Color fundus image, 2352x1568px, FOV: 45 degrees.
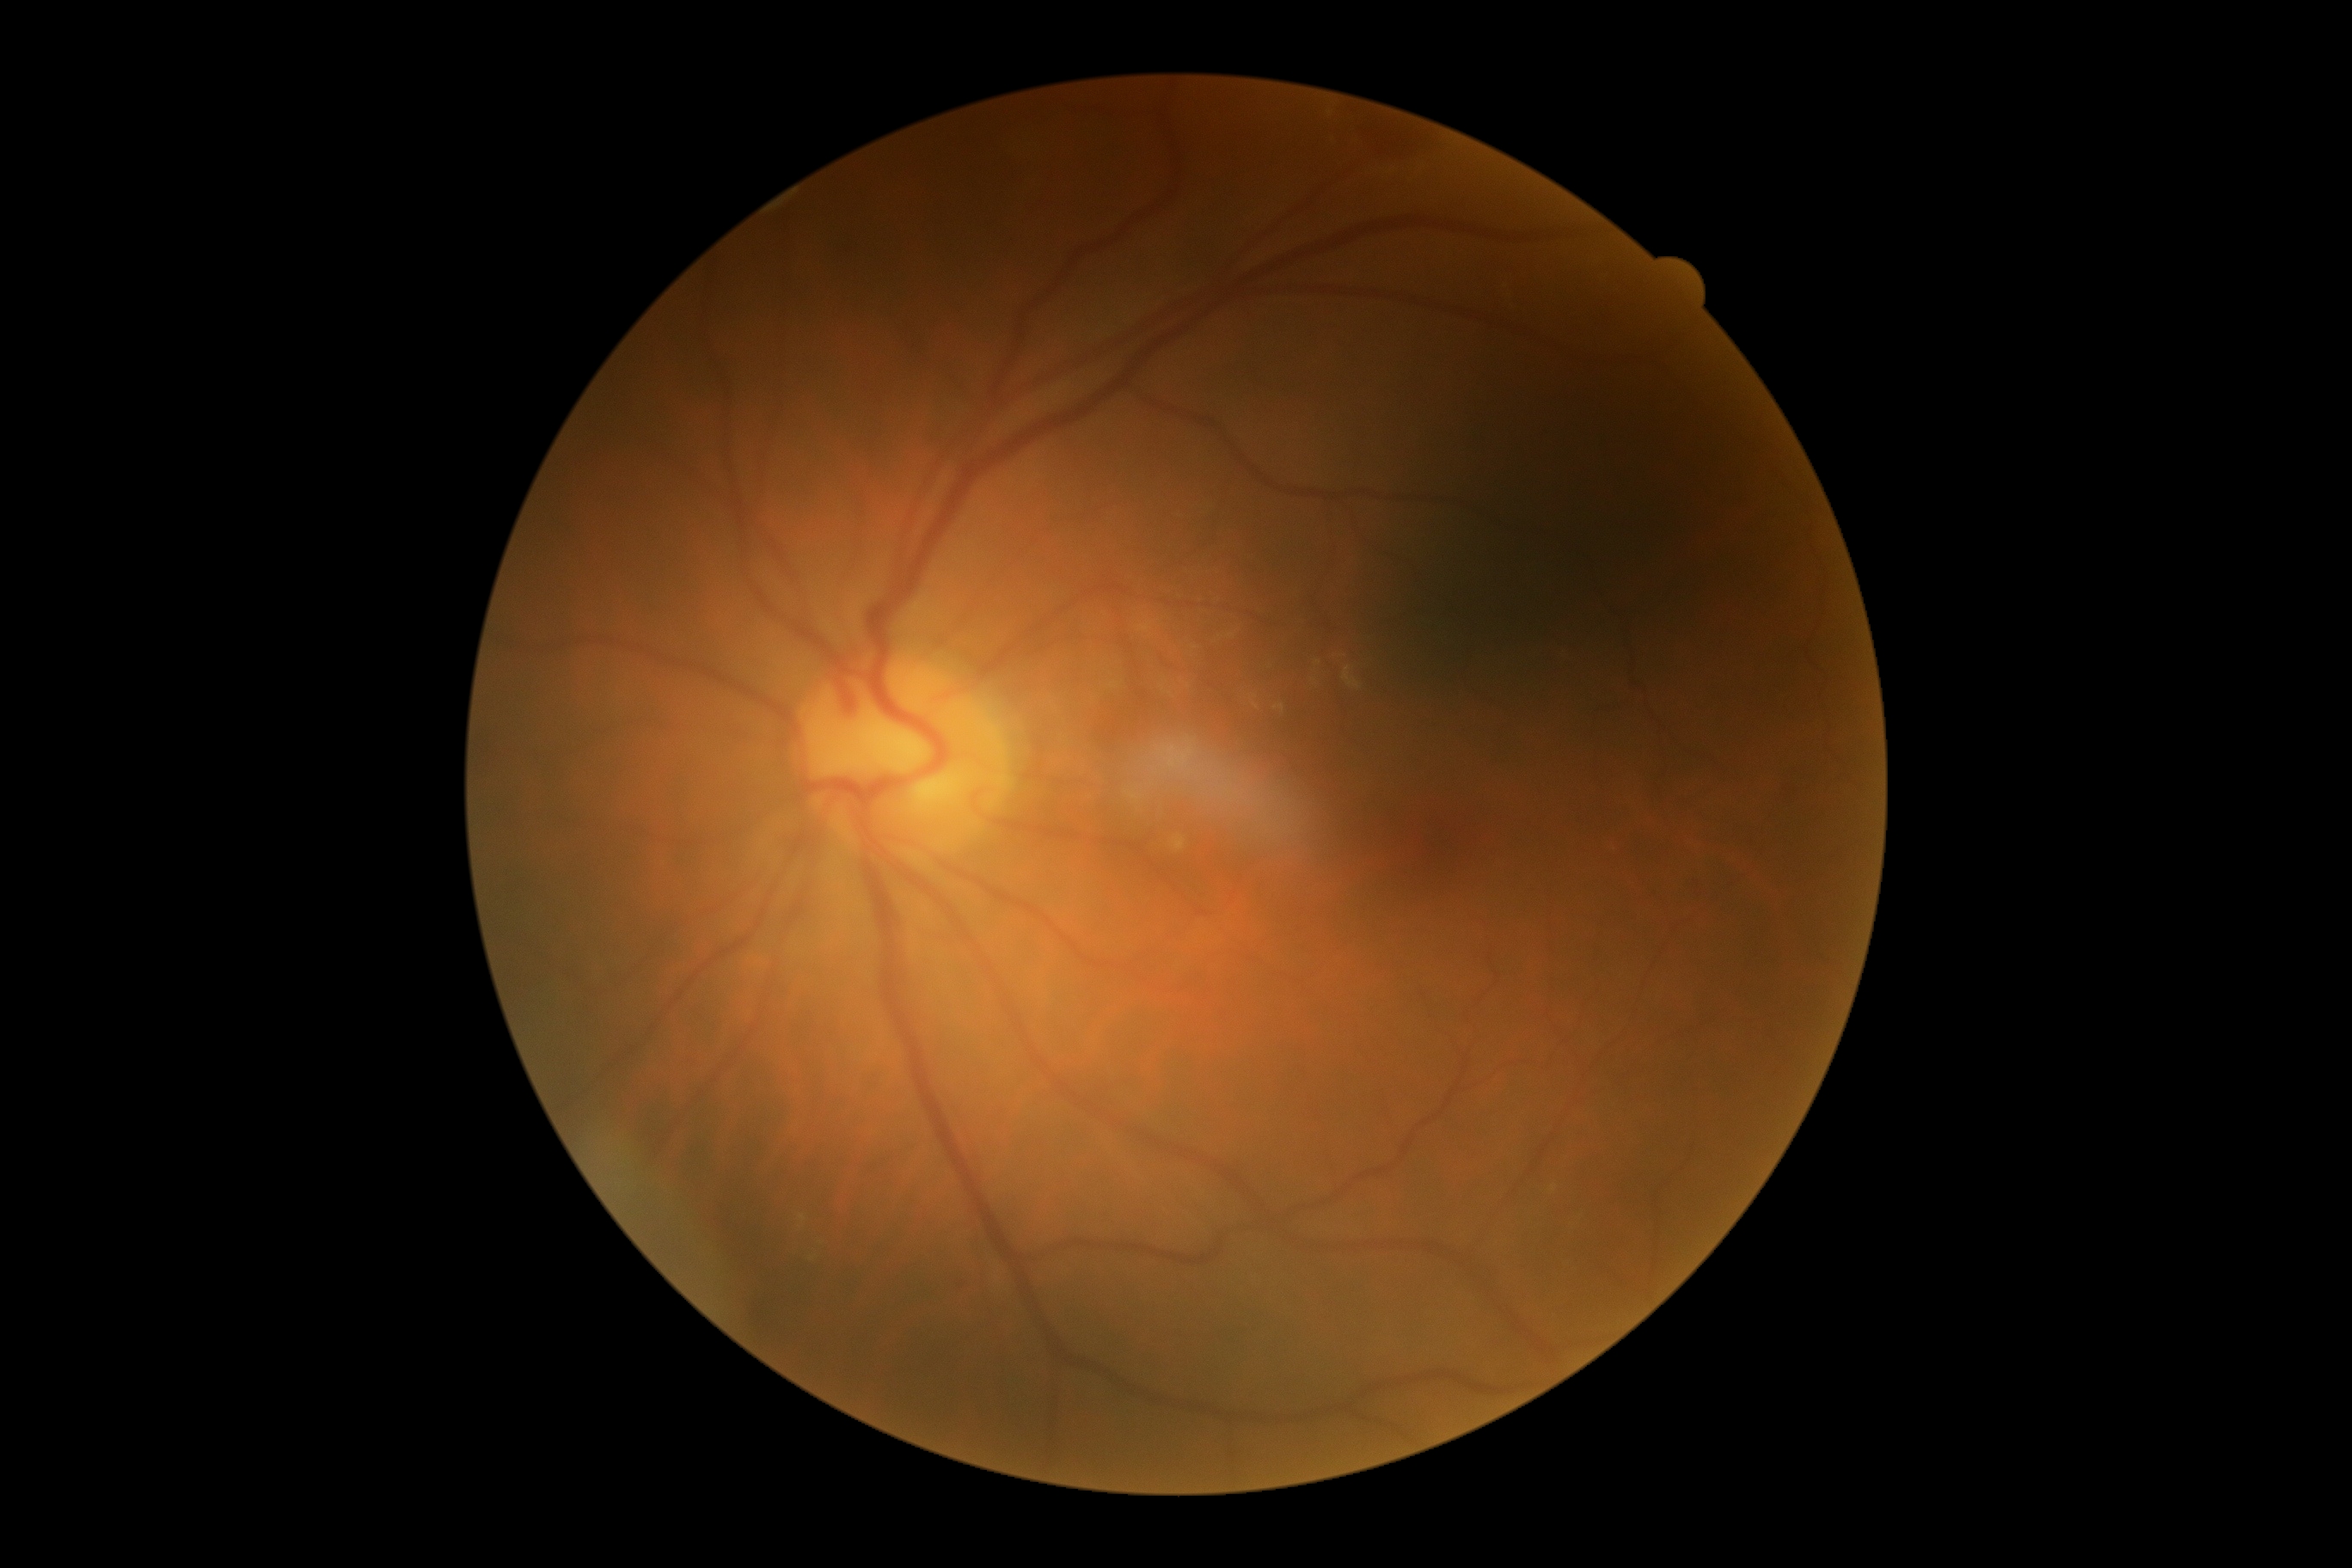 DR stage: 2/4 — more than just microaneurysms but less than severe NPDR, DR class: non-proliferative diabetic retinopathy.